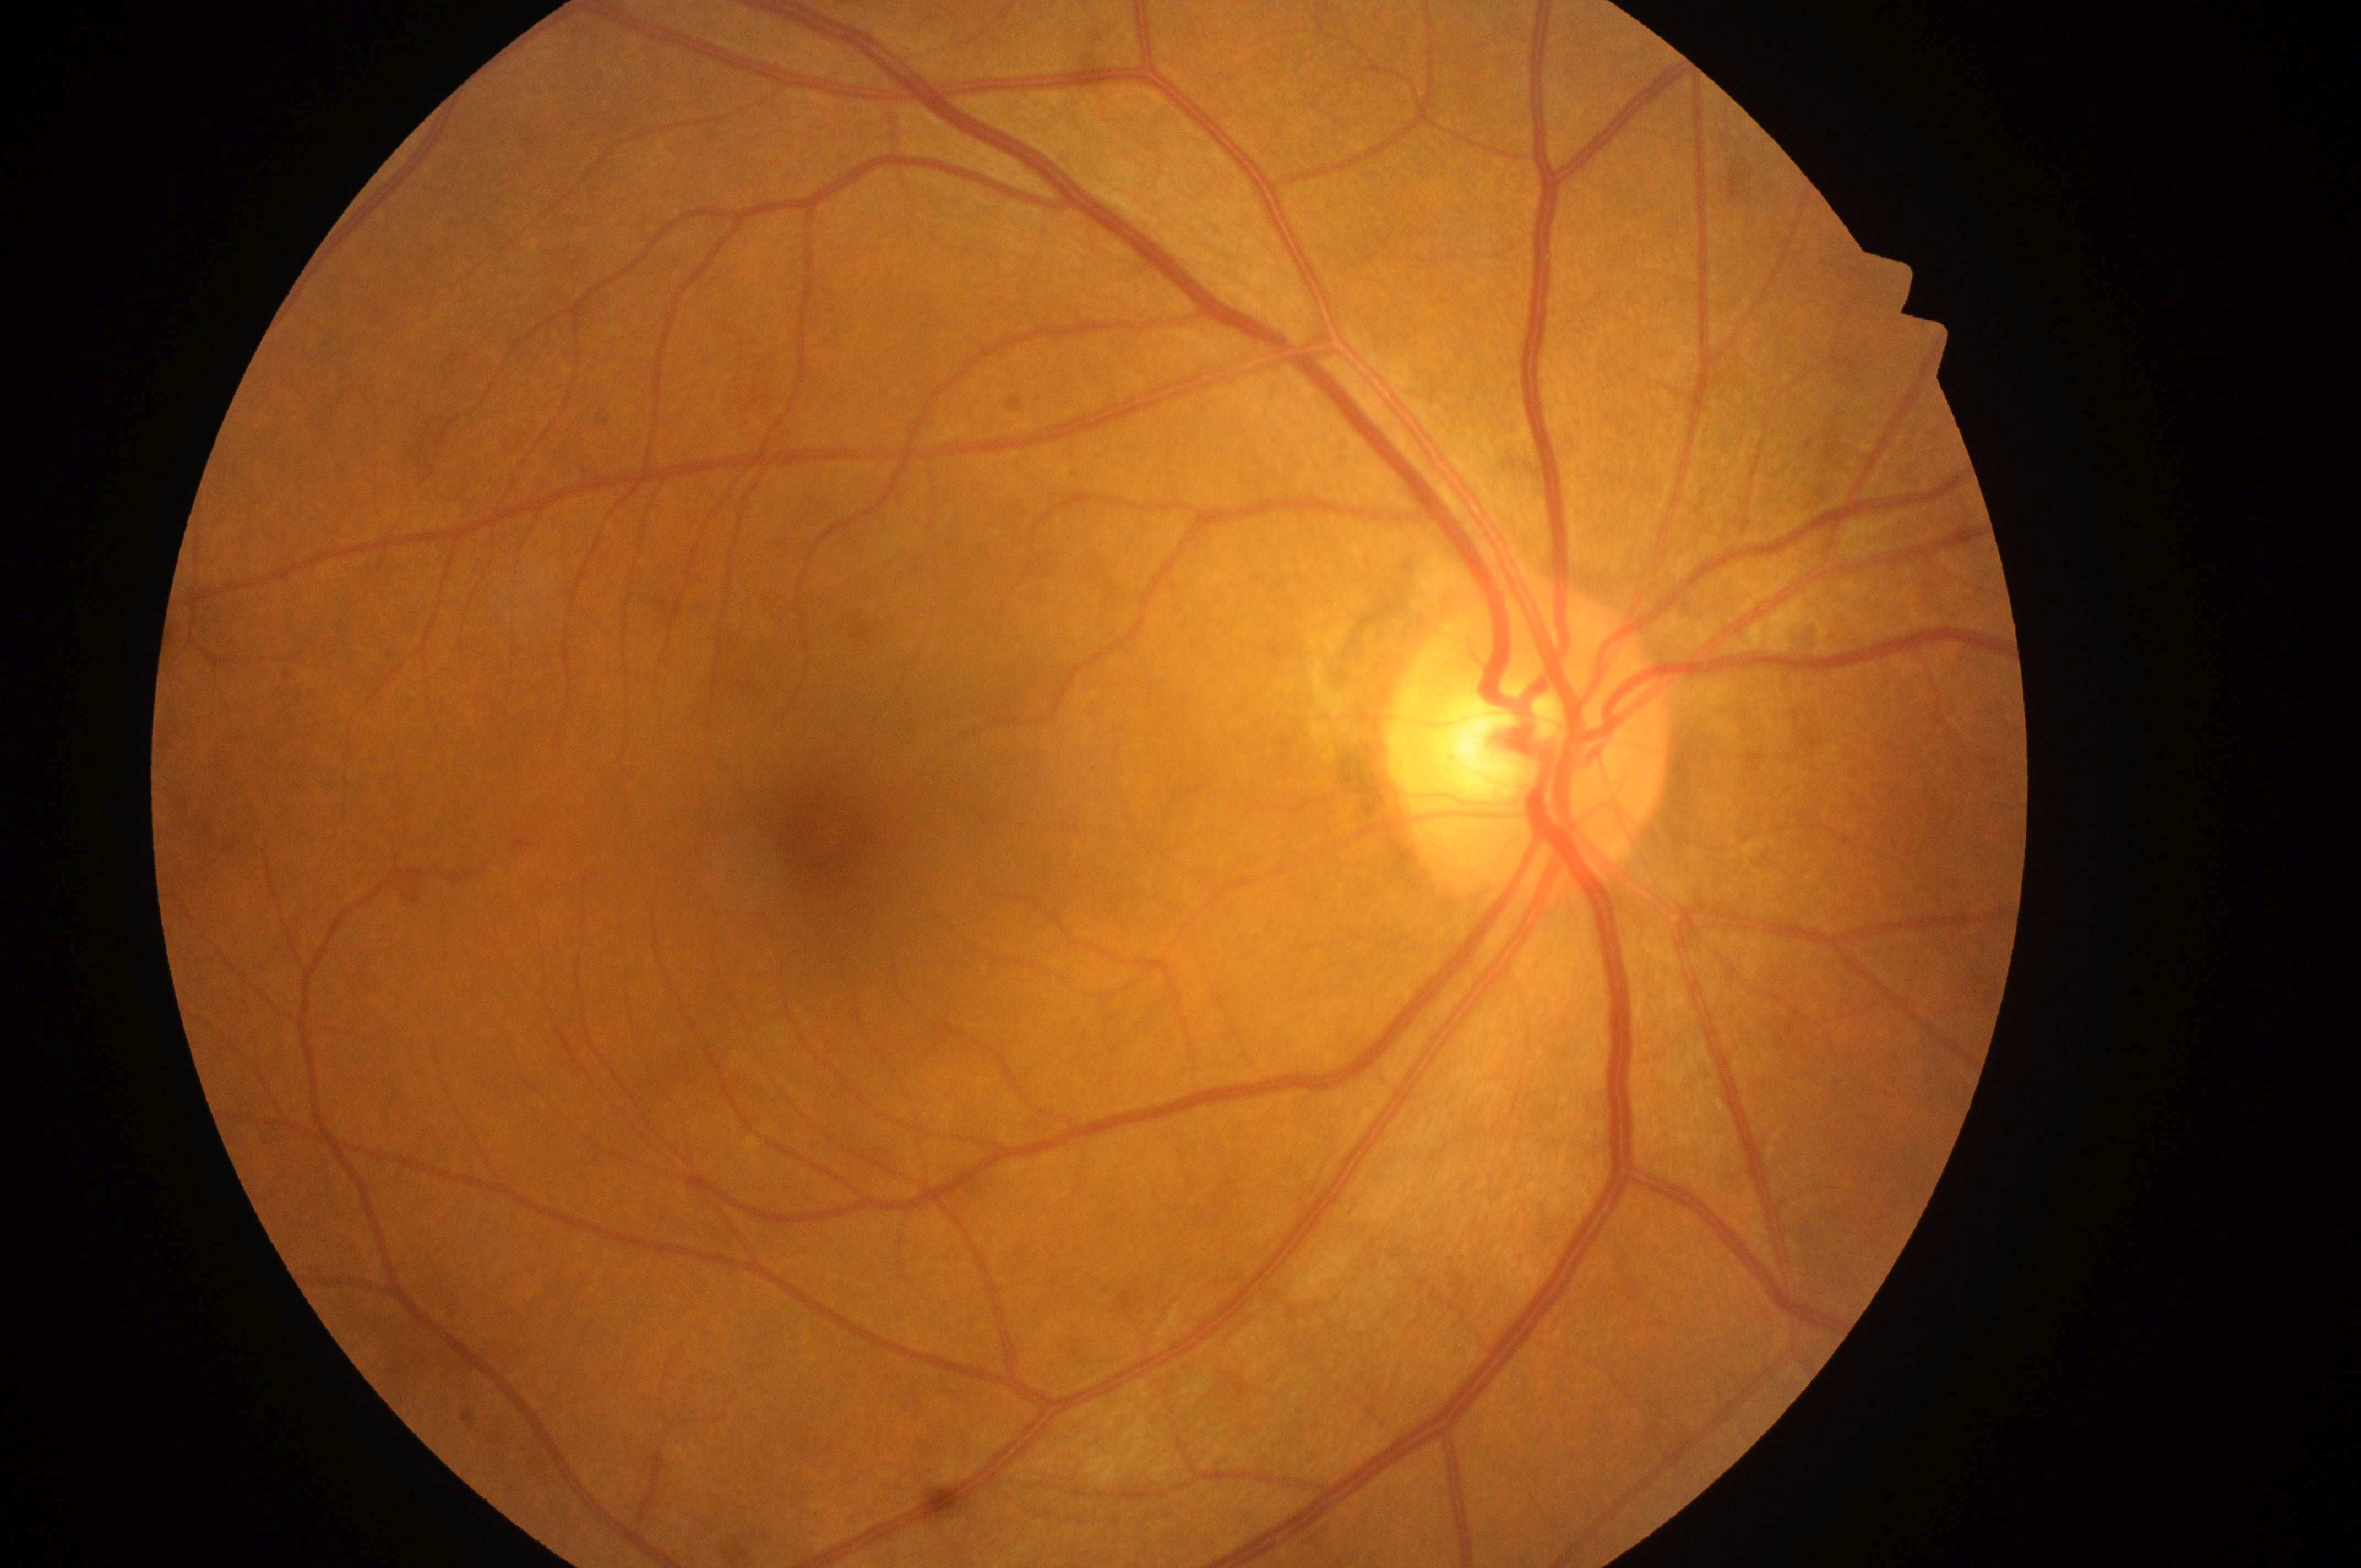
OD
diabetic retinopathy (DR)@0/4
diabetic macular edema (DME)@0/2
the optic disc@[1526, 759]
foveal center@[823, 847]